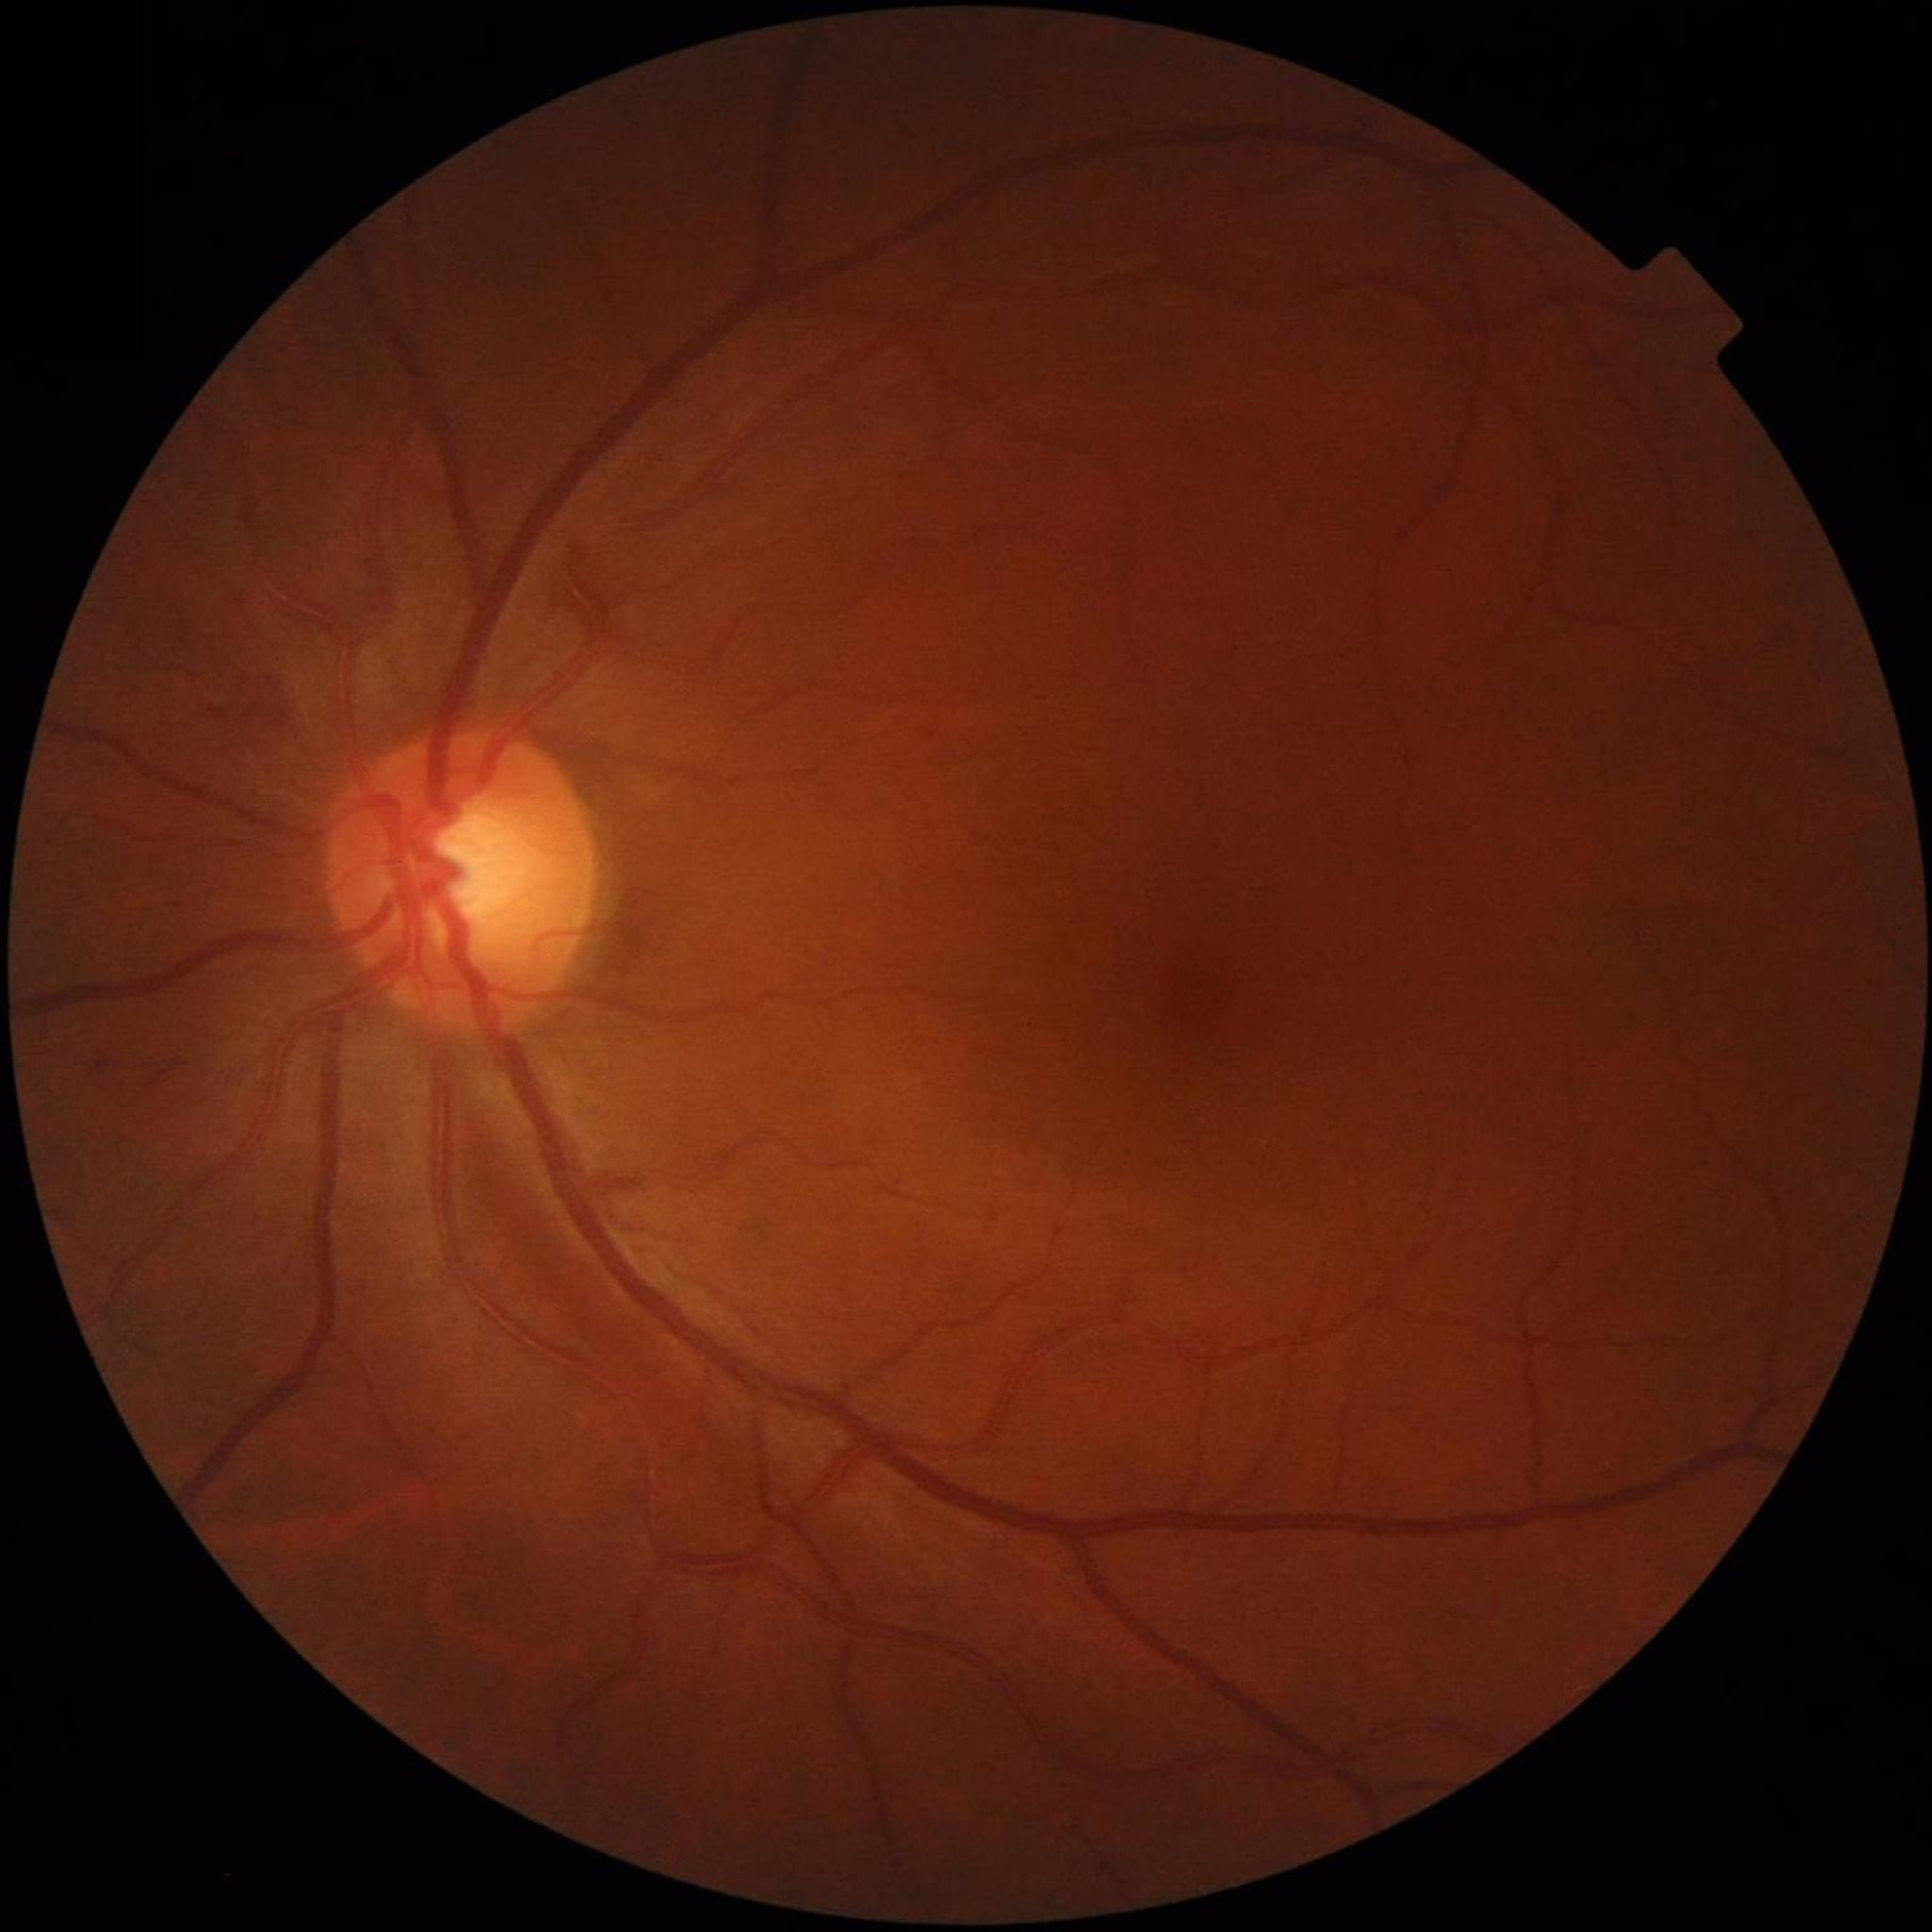 Automated quality assessment: satisfactory. Control patient without diagnosed AMD, DR, or glaucoma.